45-degree field of view · without pupil dilation · NIDEK AFC-230 · 848x848px:
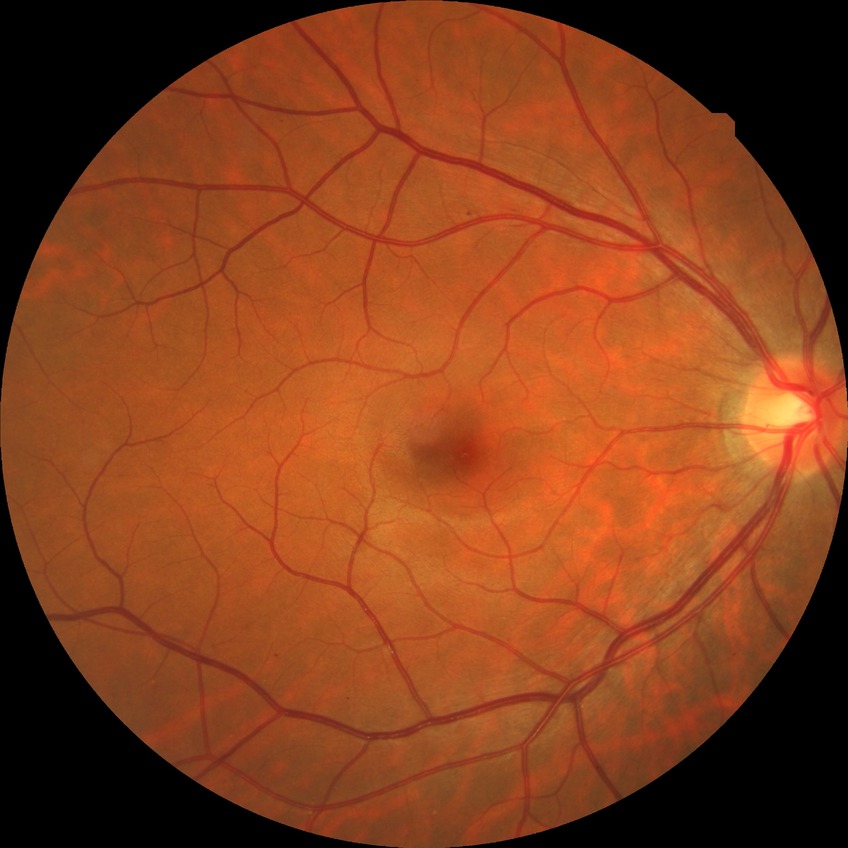
retinopathy stage: simple diabetic retinopathy.